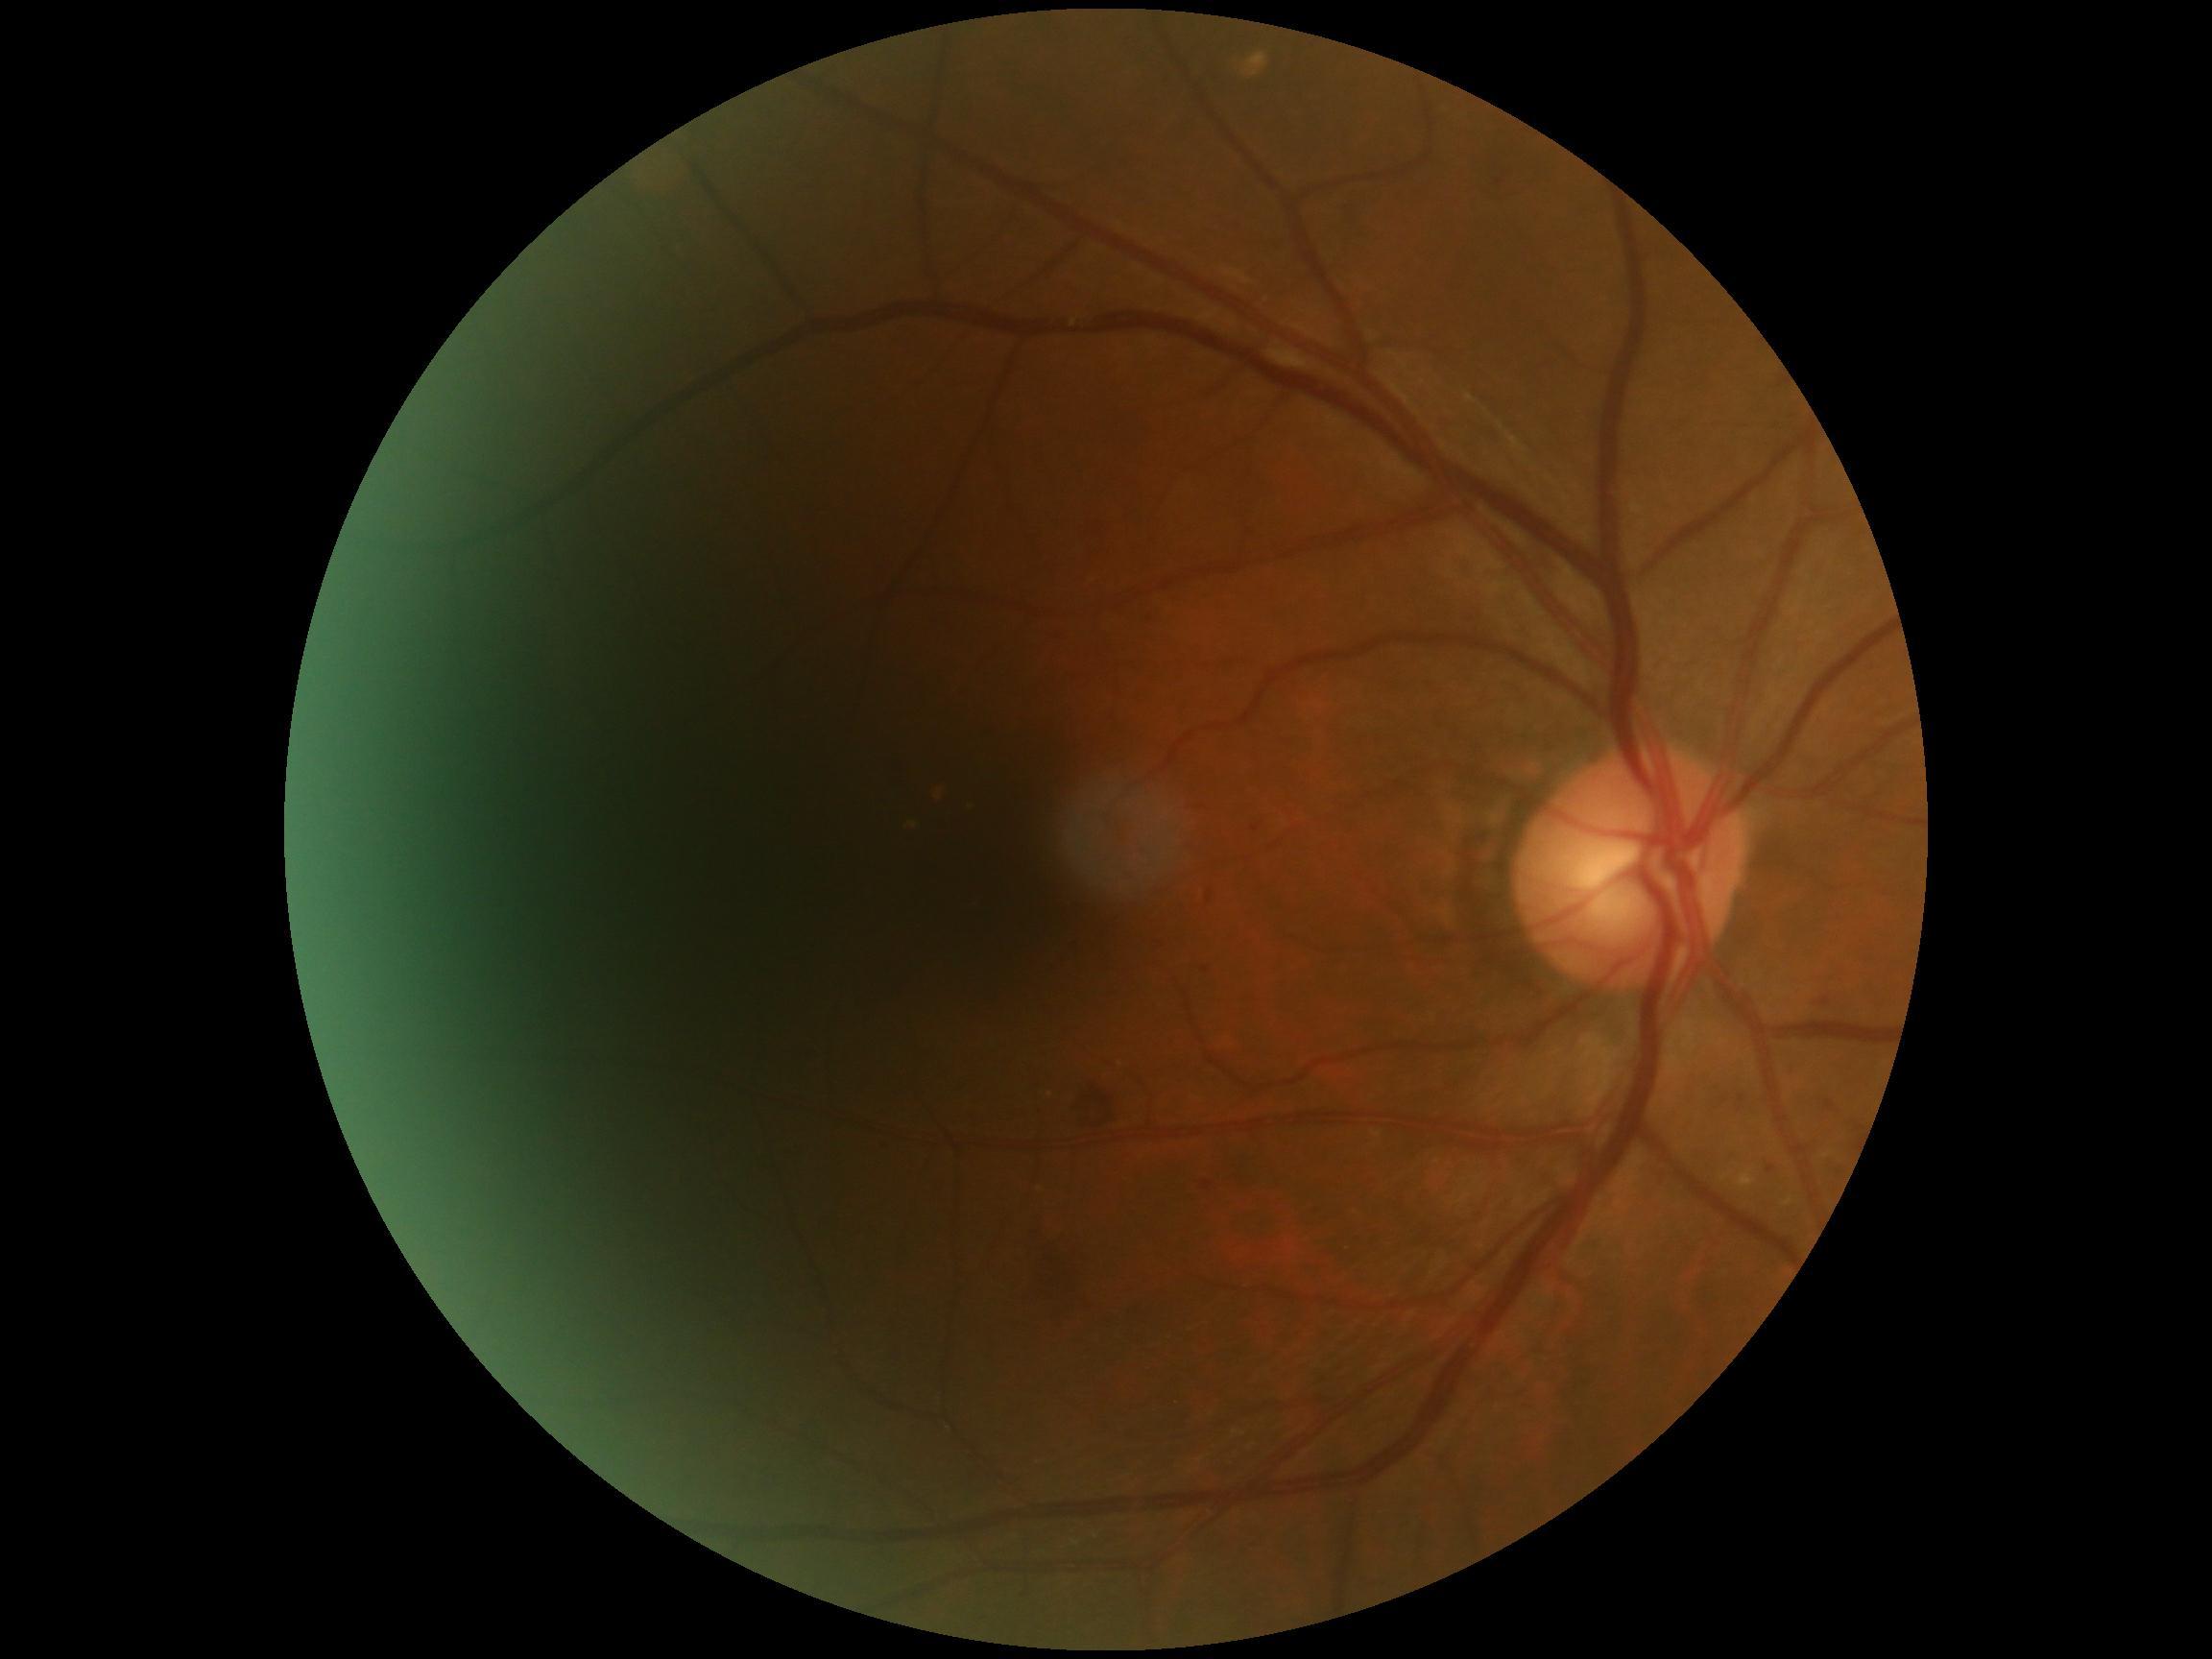 DR is 2/4.